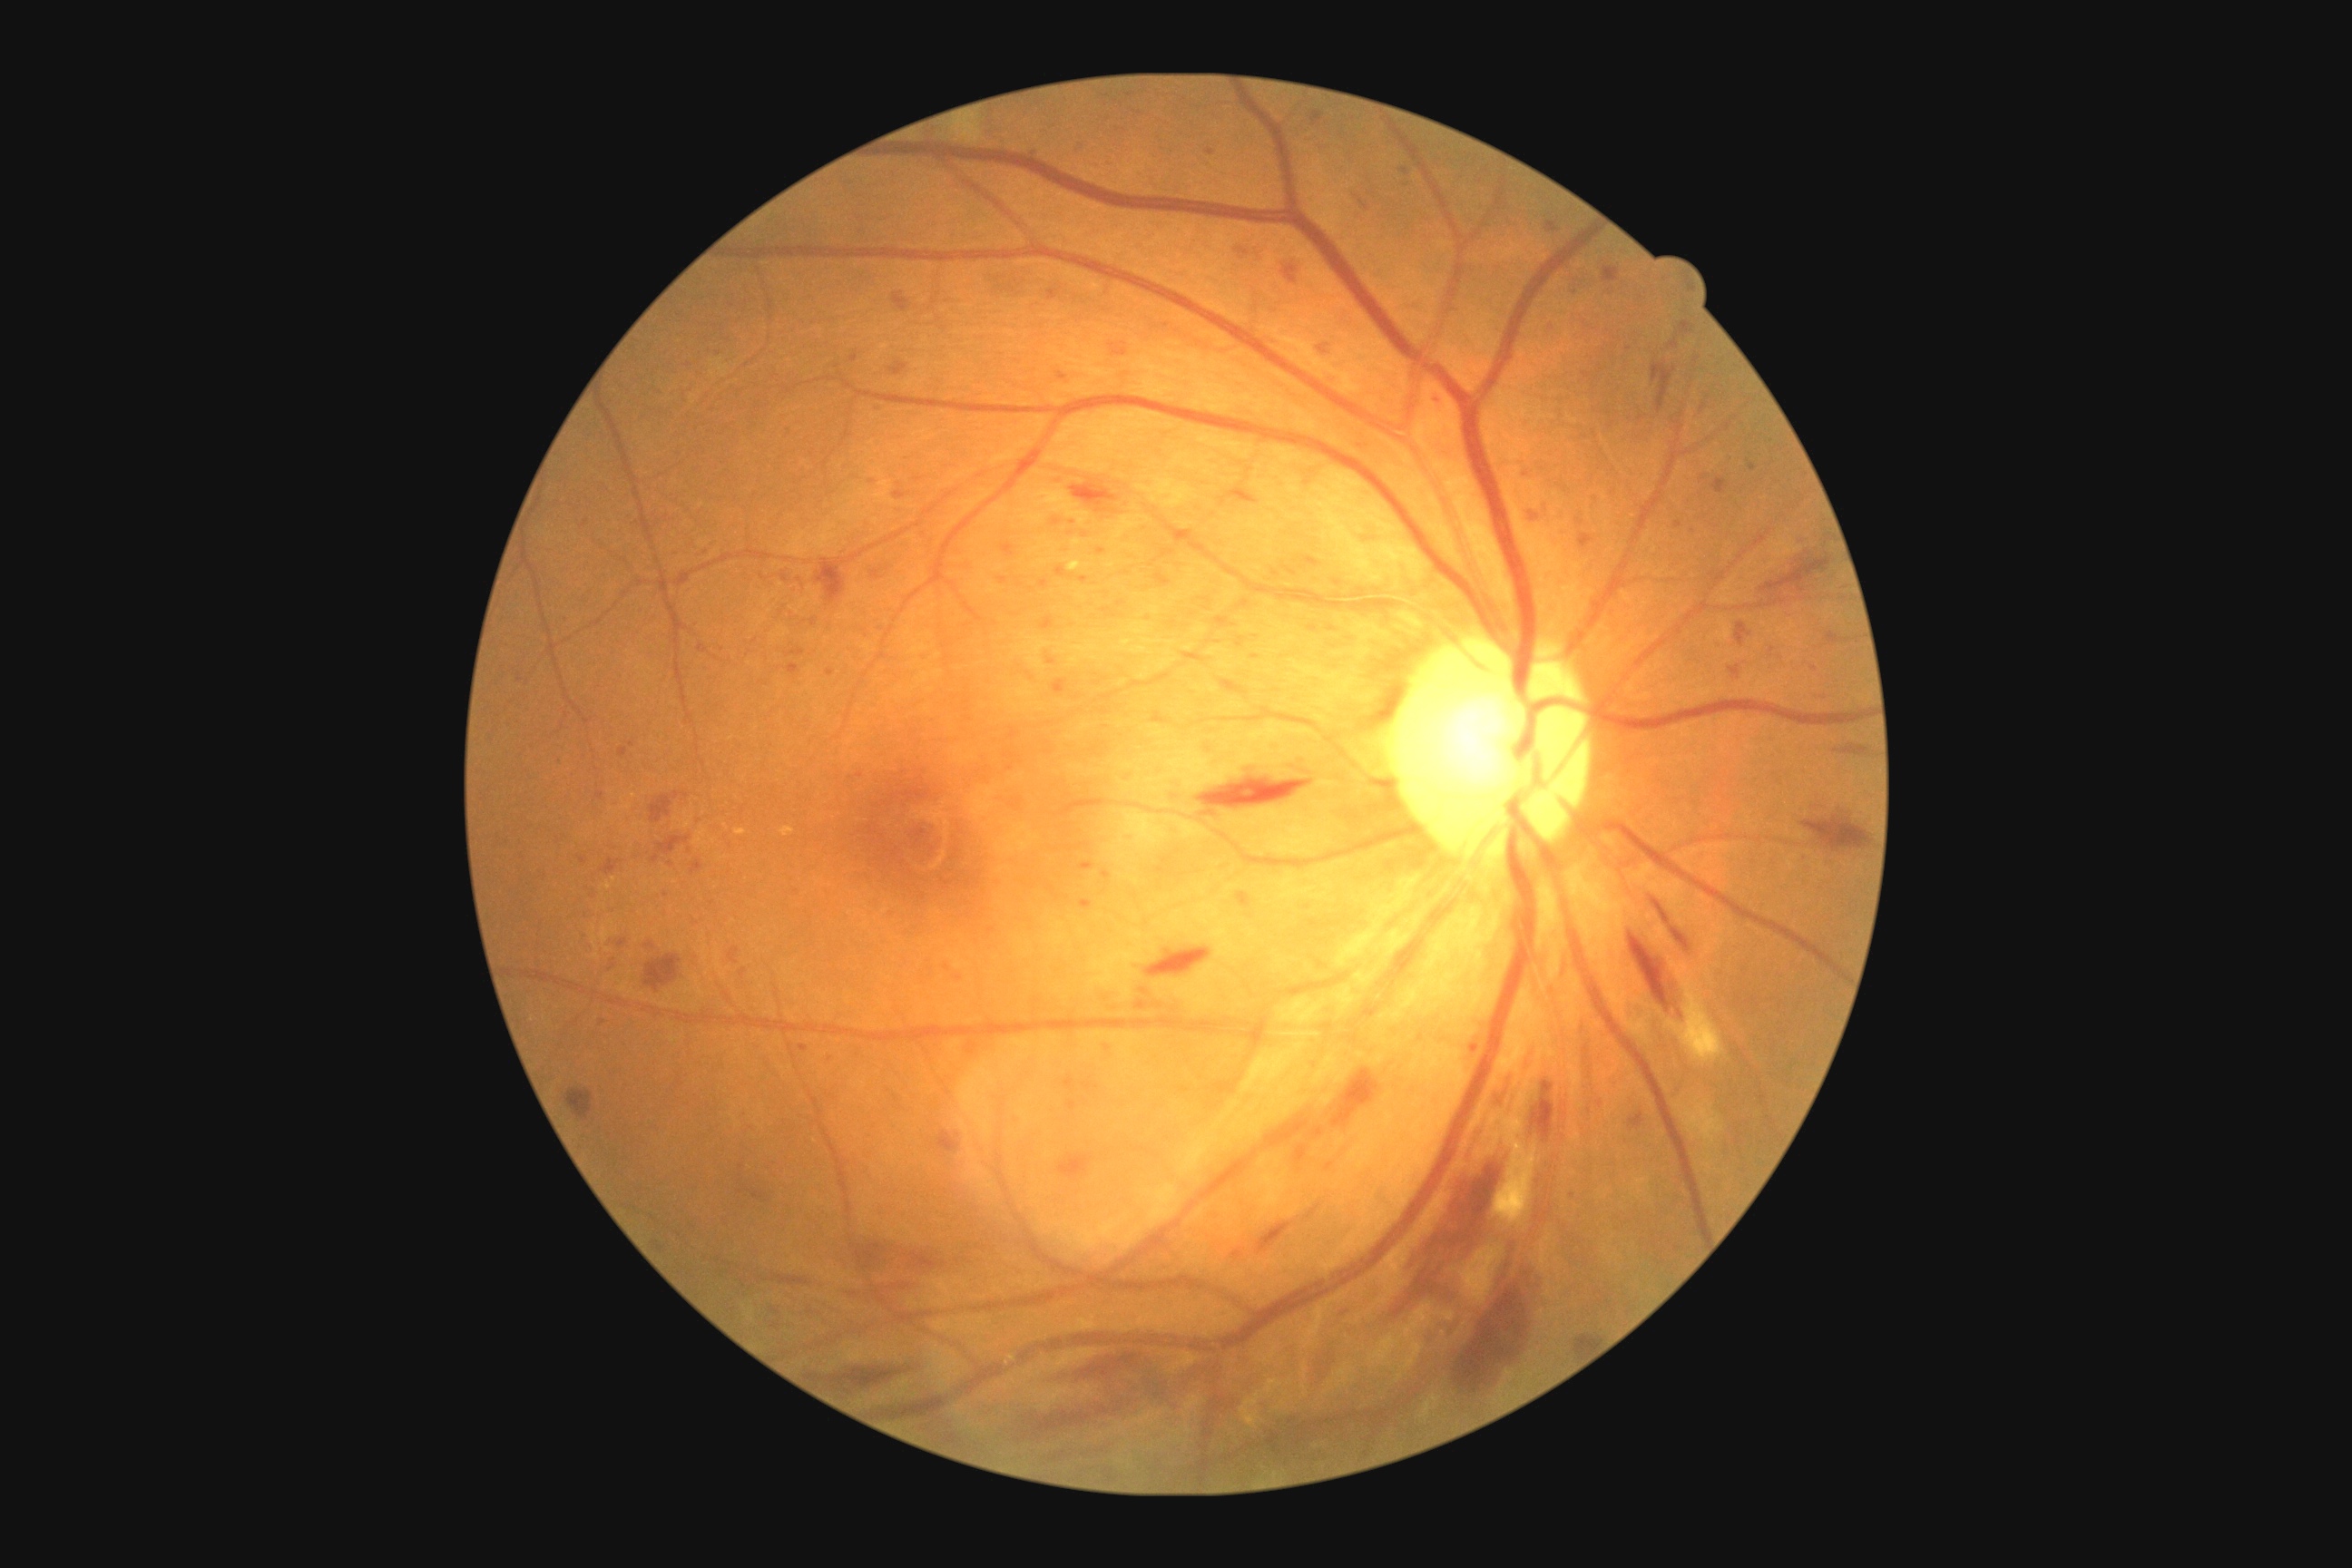
The retinopathy is classified as non-proliferative diabetic retinopathy.
DR severity is 3.